Color fundus photograph · 45° FOV · DR severity per modified Davis staging: 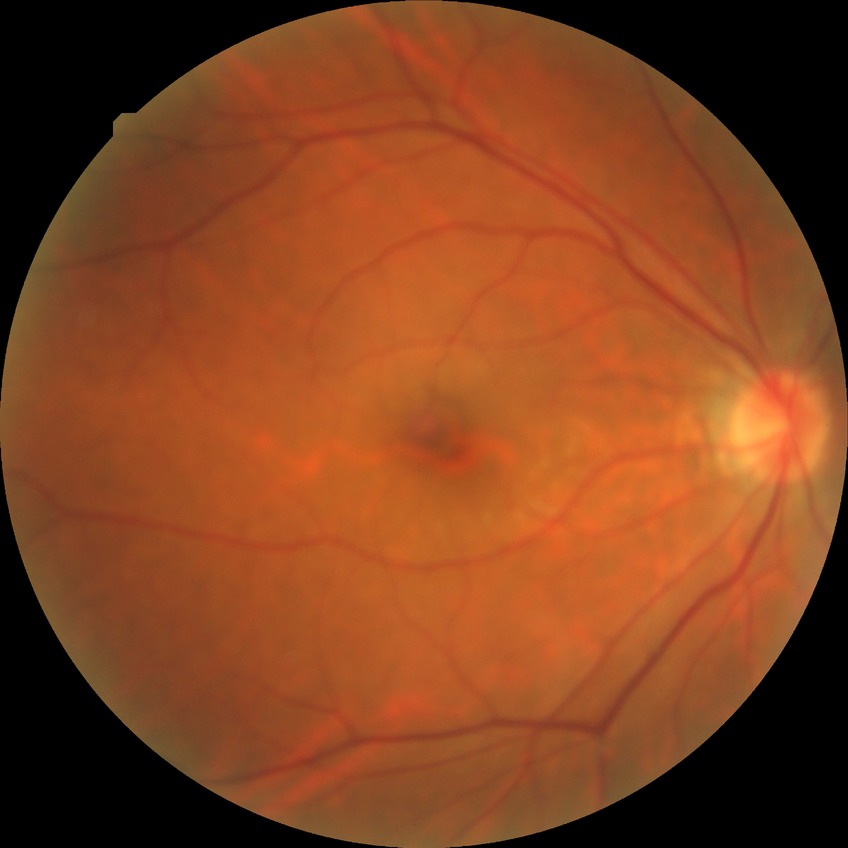 Davis grade=NDR.